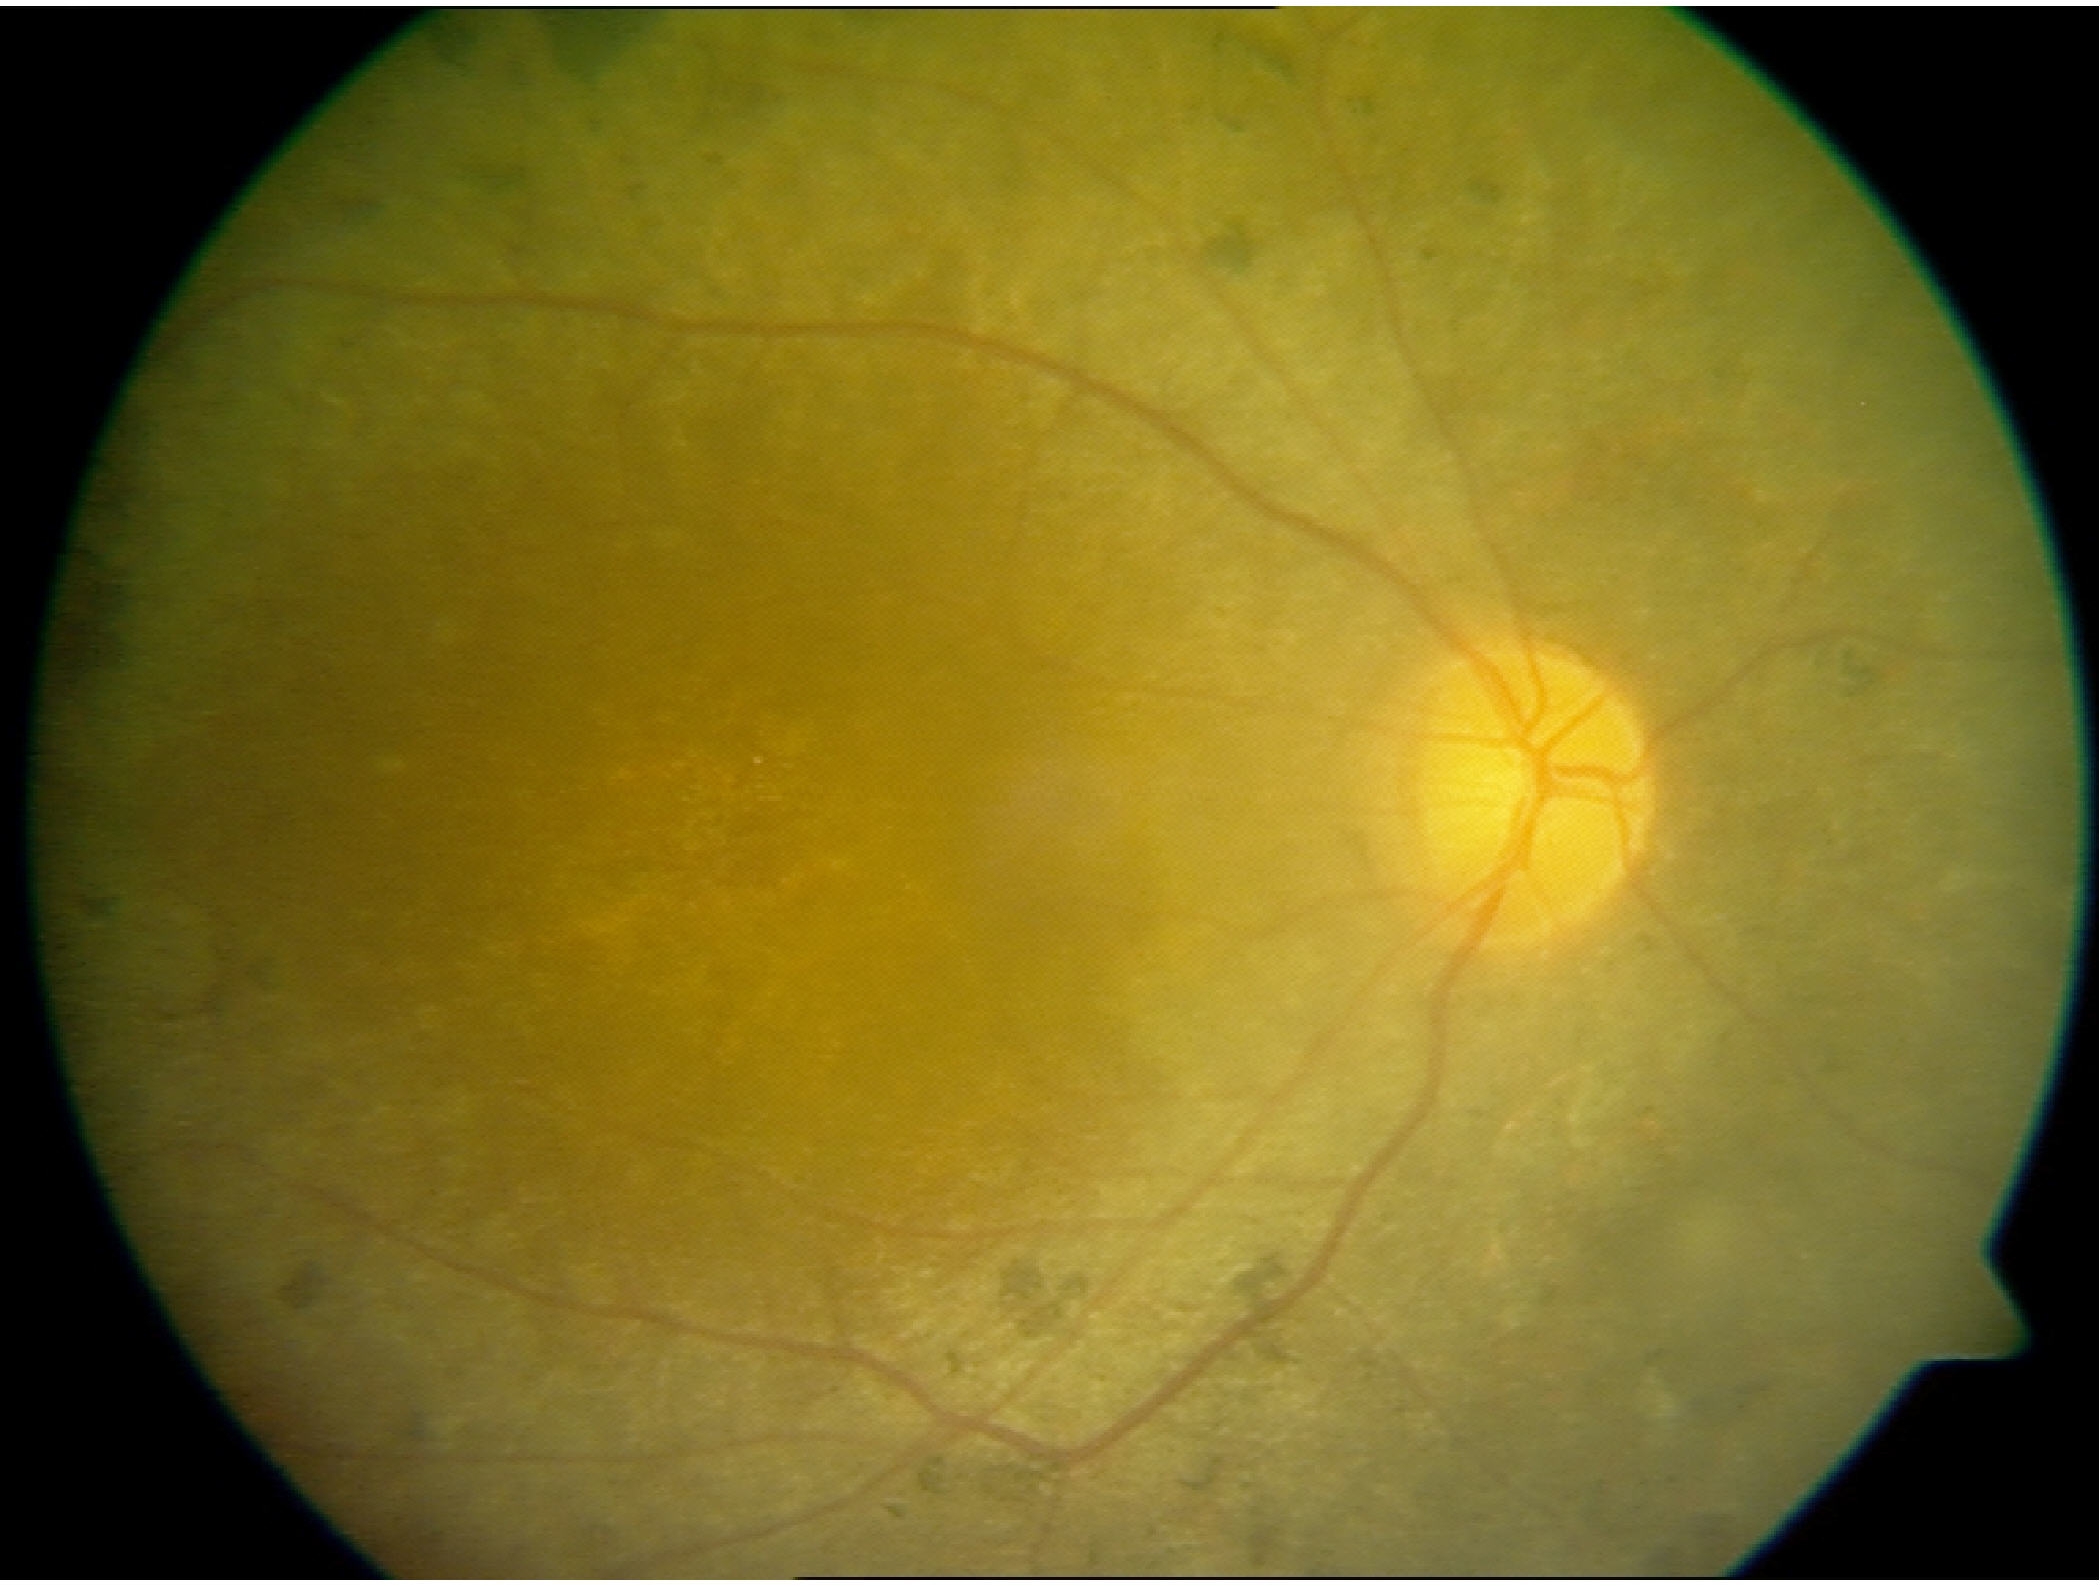
Classification: retinitis pigmentosa.